Fundus photo
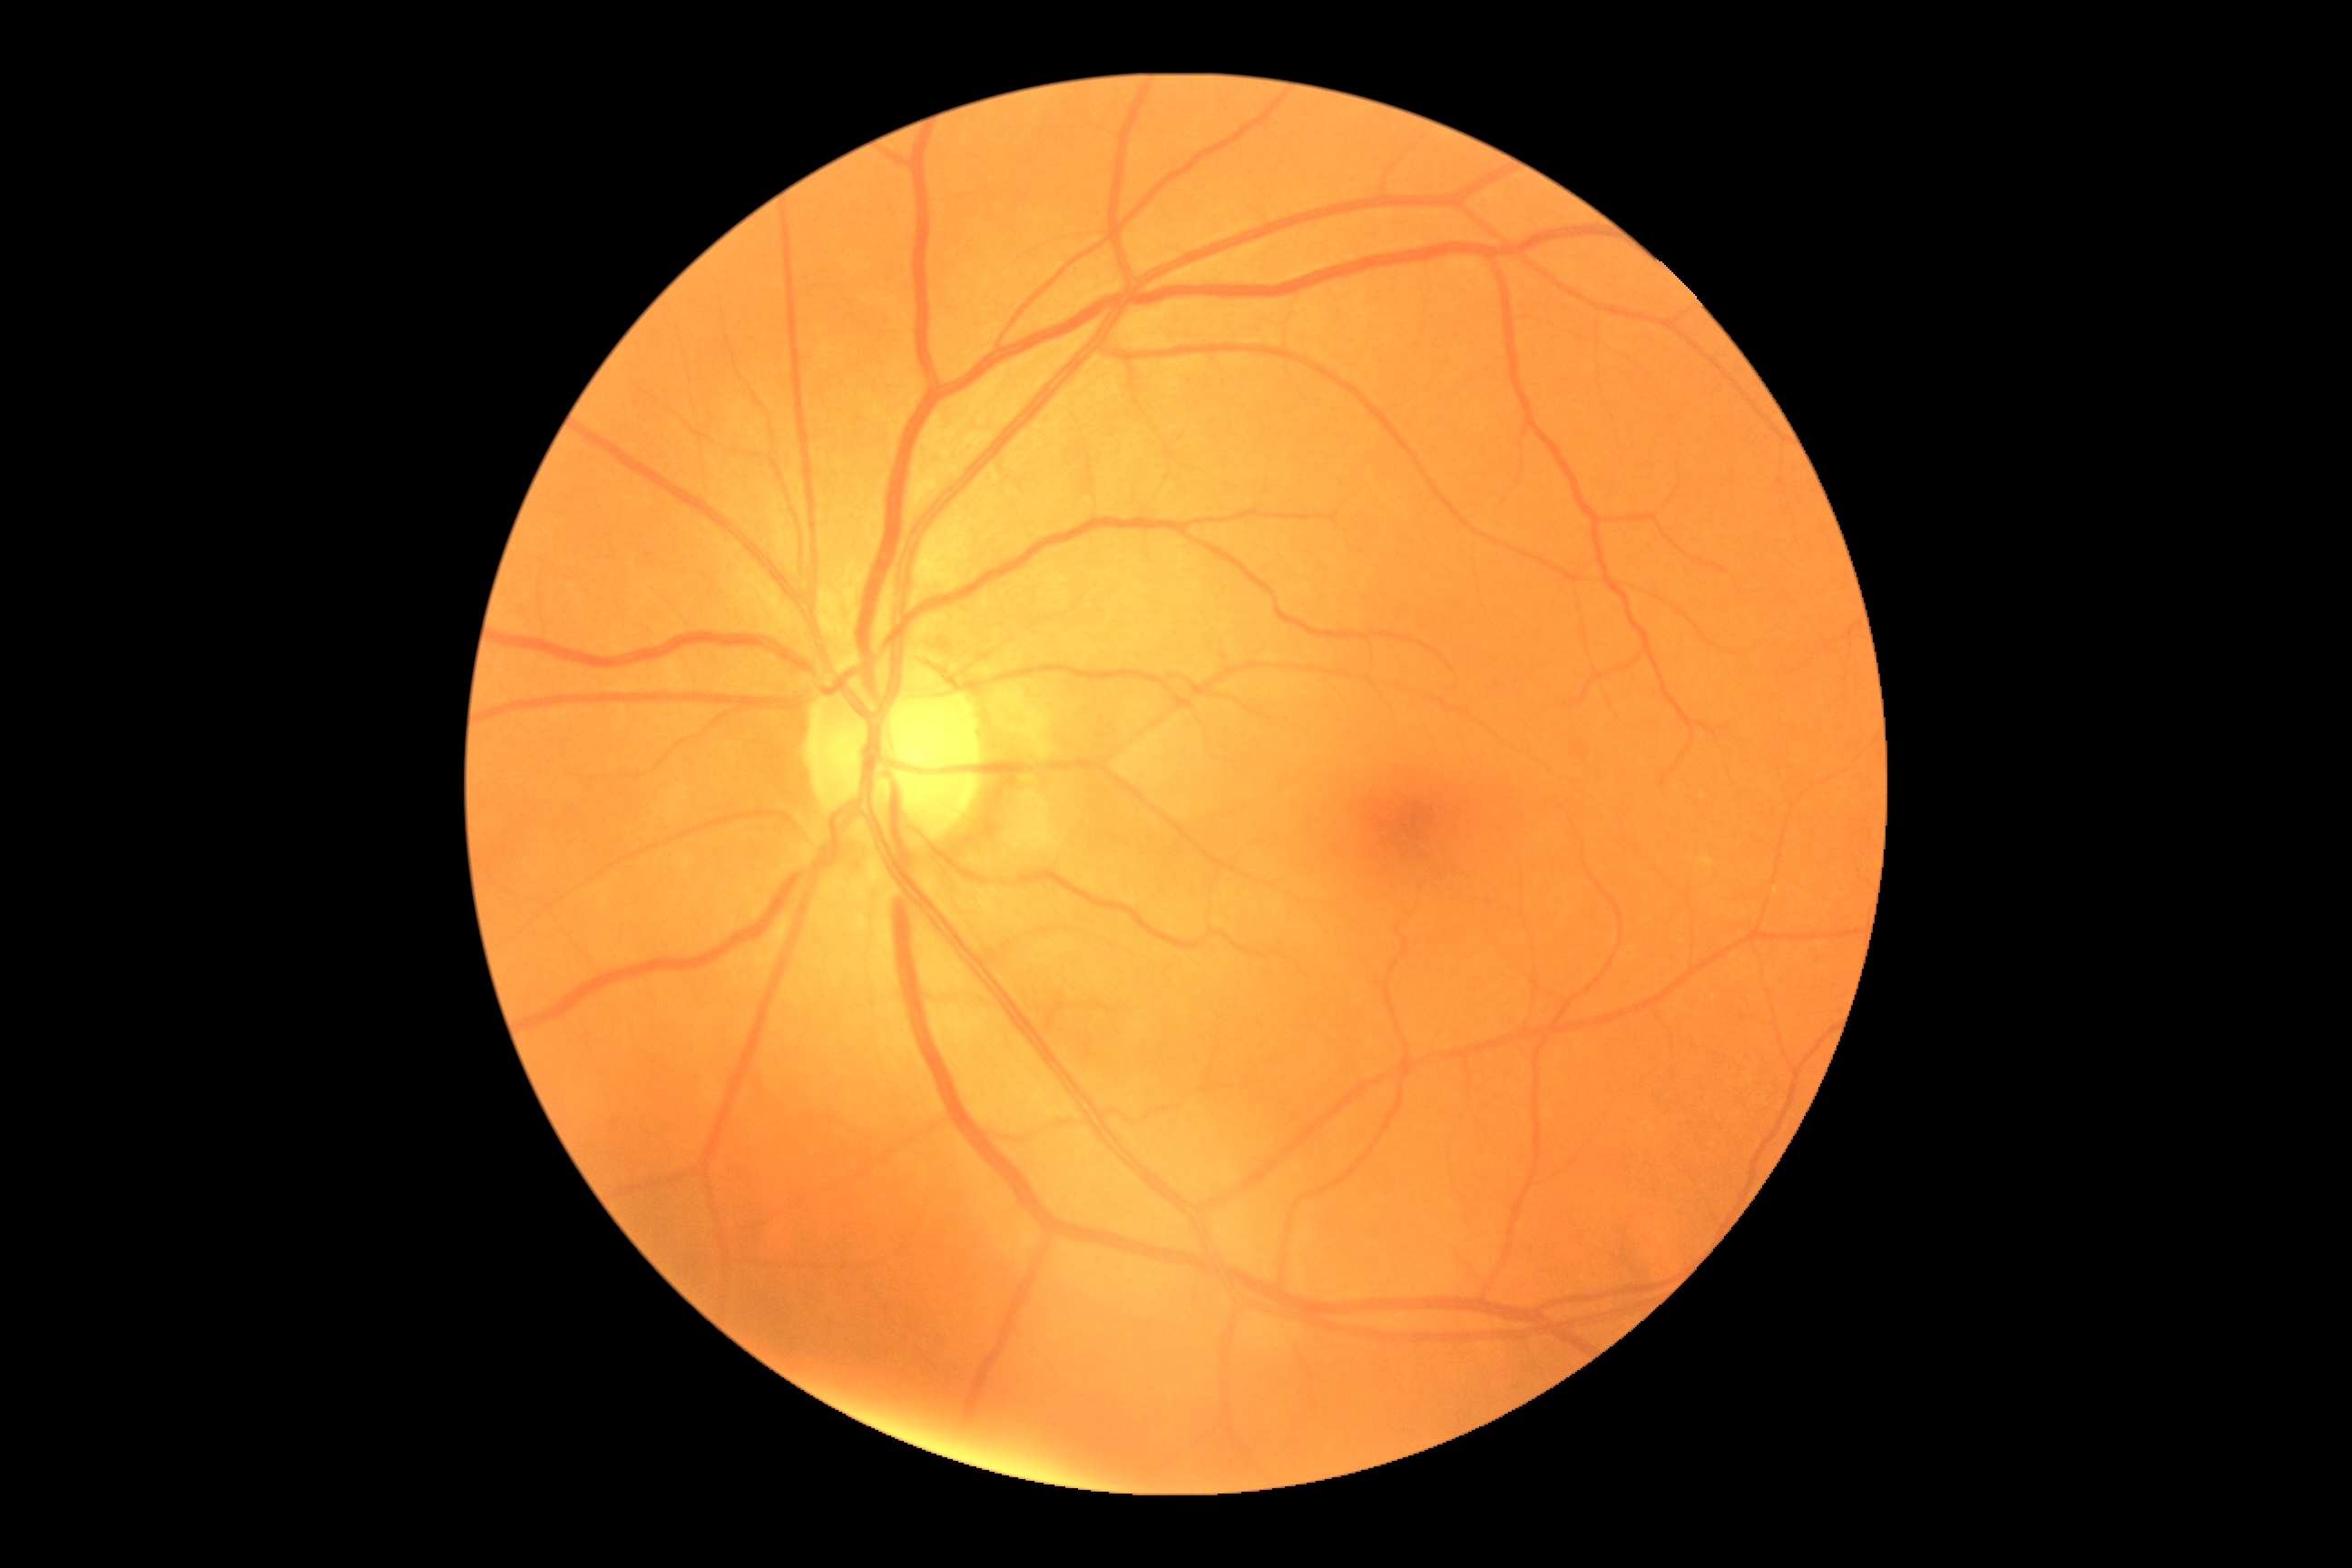
Diabetic retinopathy (DR) is grade 0.